45° field of view — 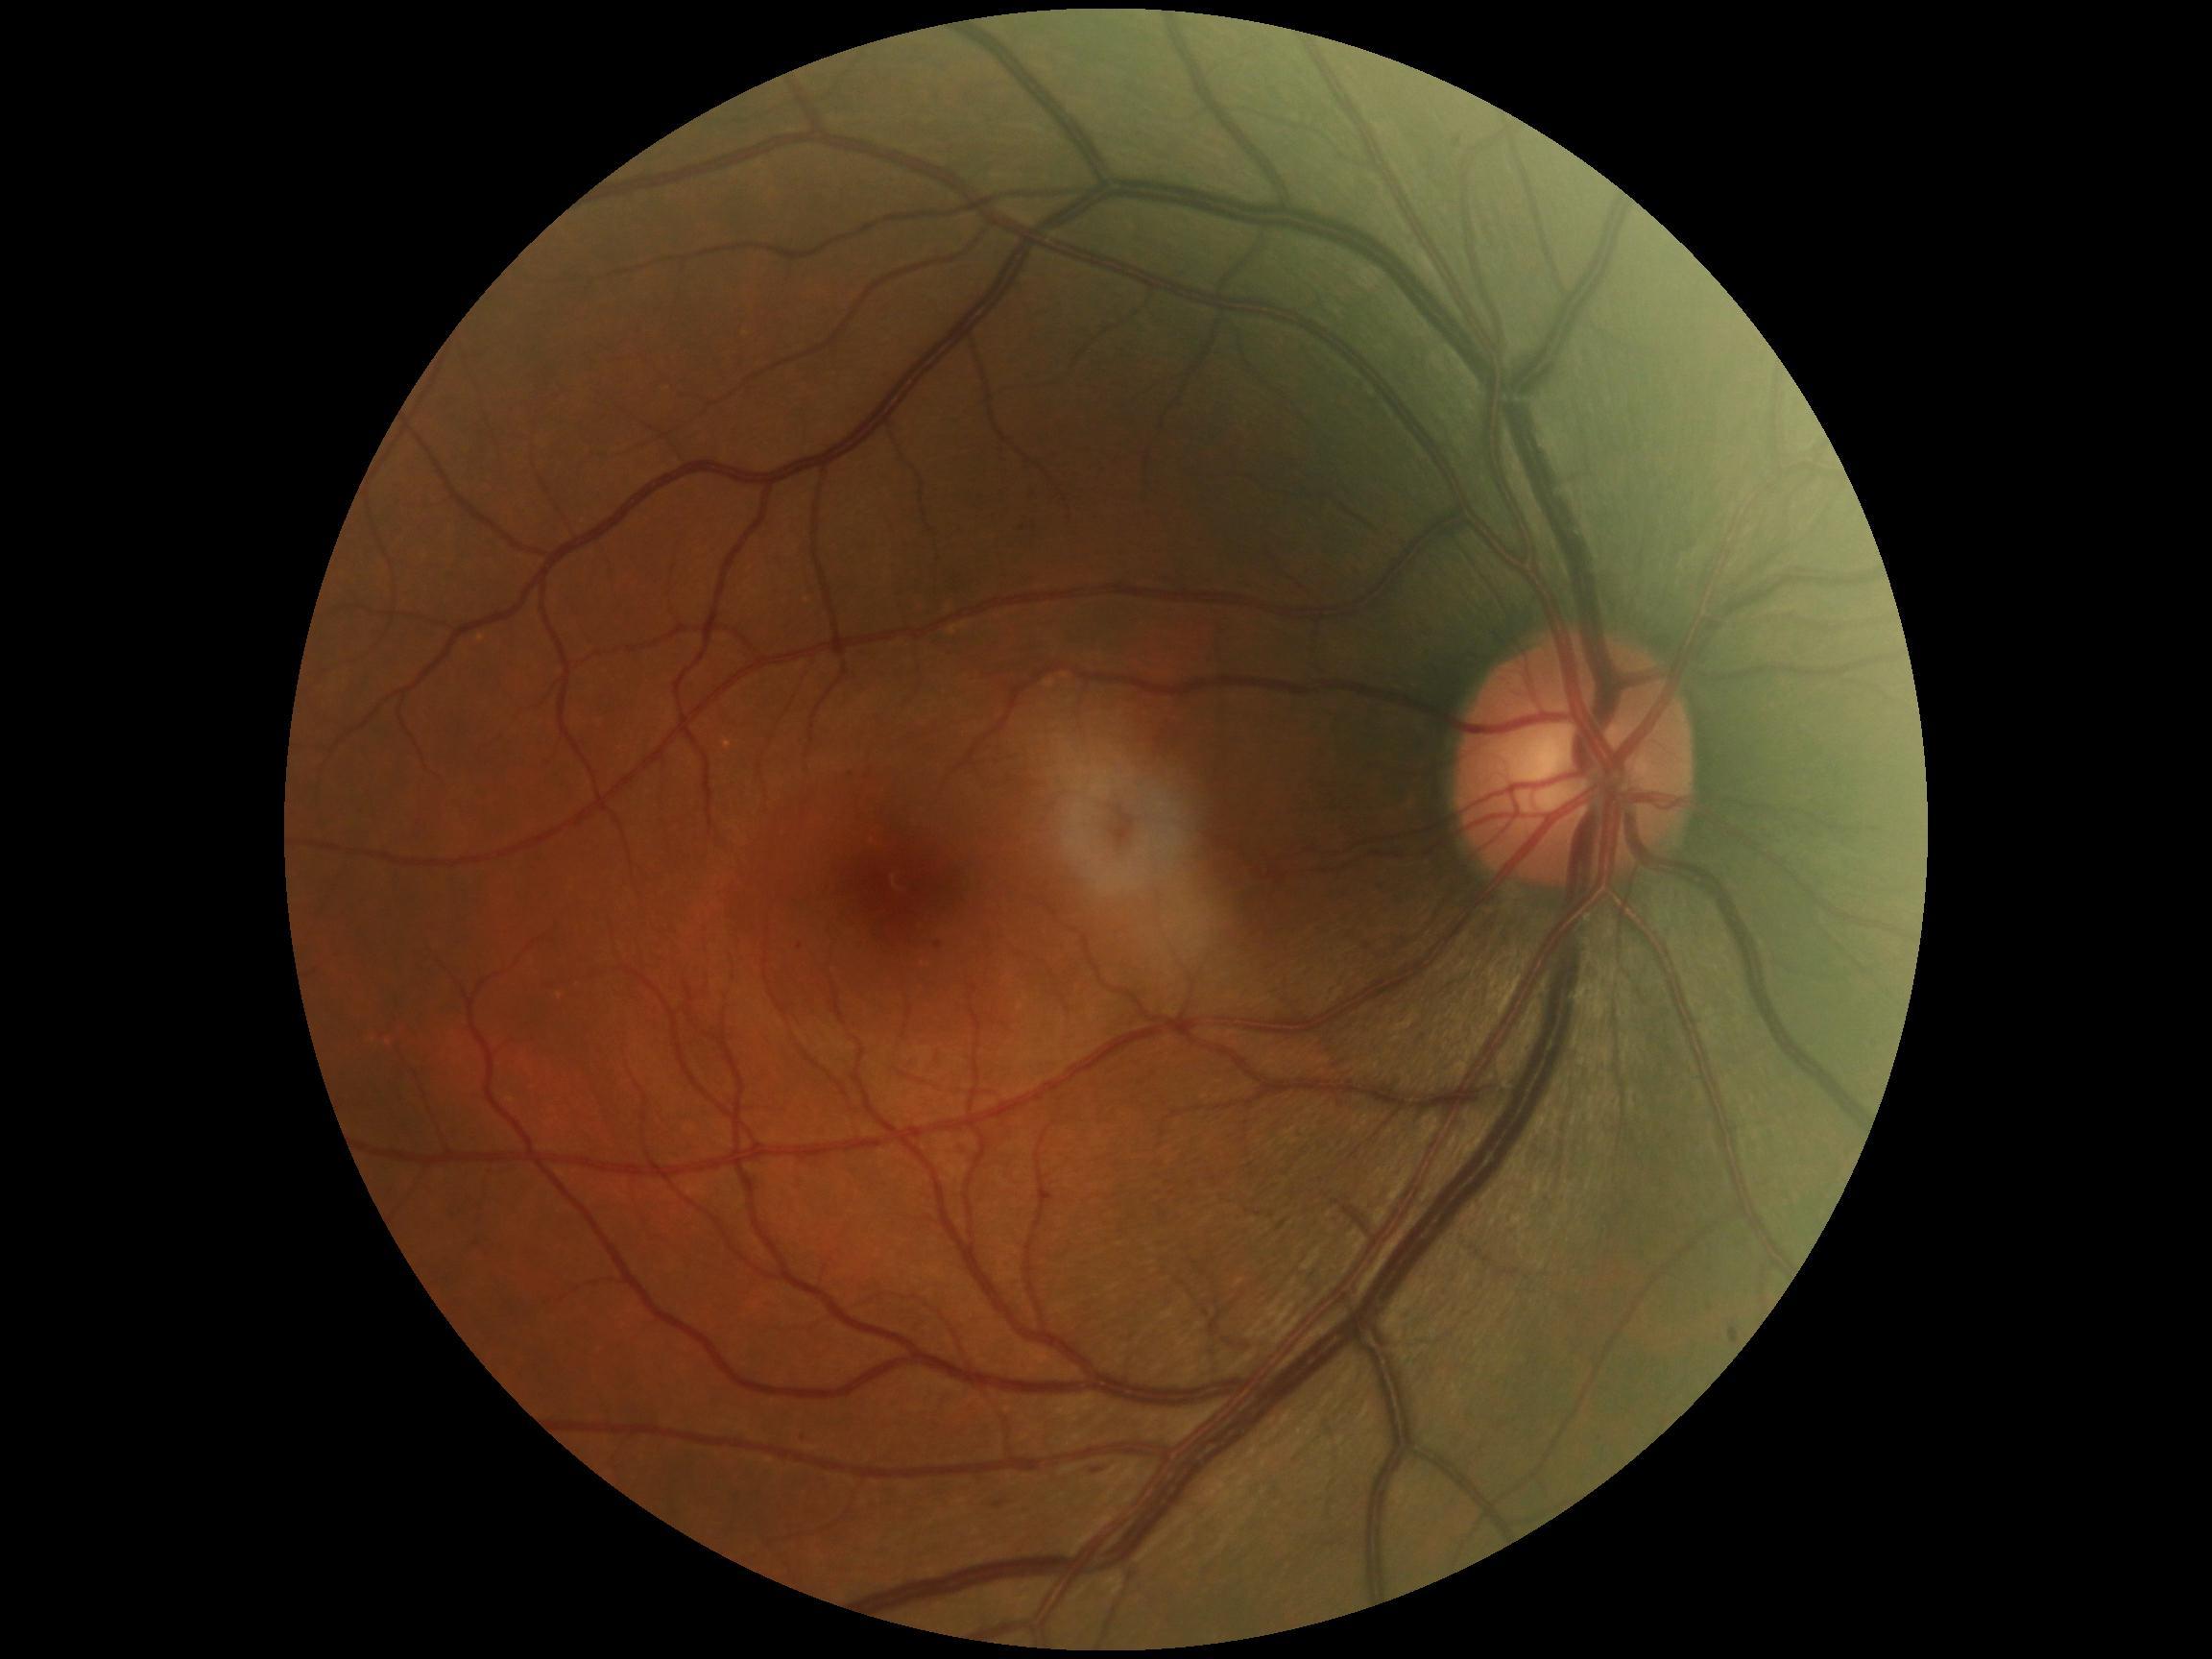

DR class: non-proliferative diabetic retinopathy; diabetic retinopathy (DR): mild non-proliferative diabetic retinopathy (grade 1) — presence of microaneurysms only.